Color fundus image
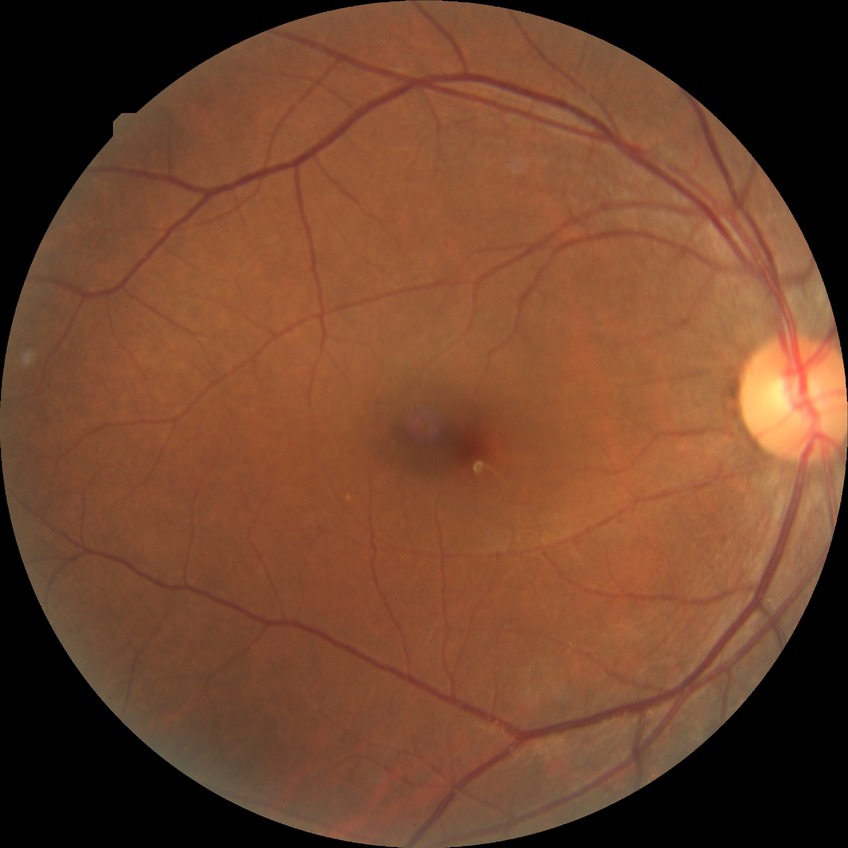

Davis DR grade is NDR.